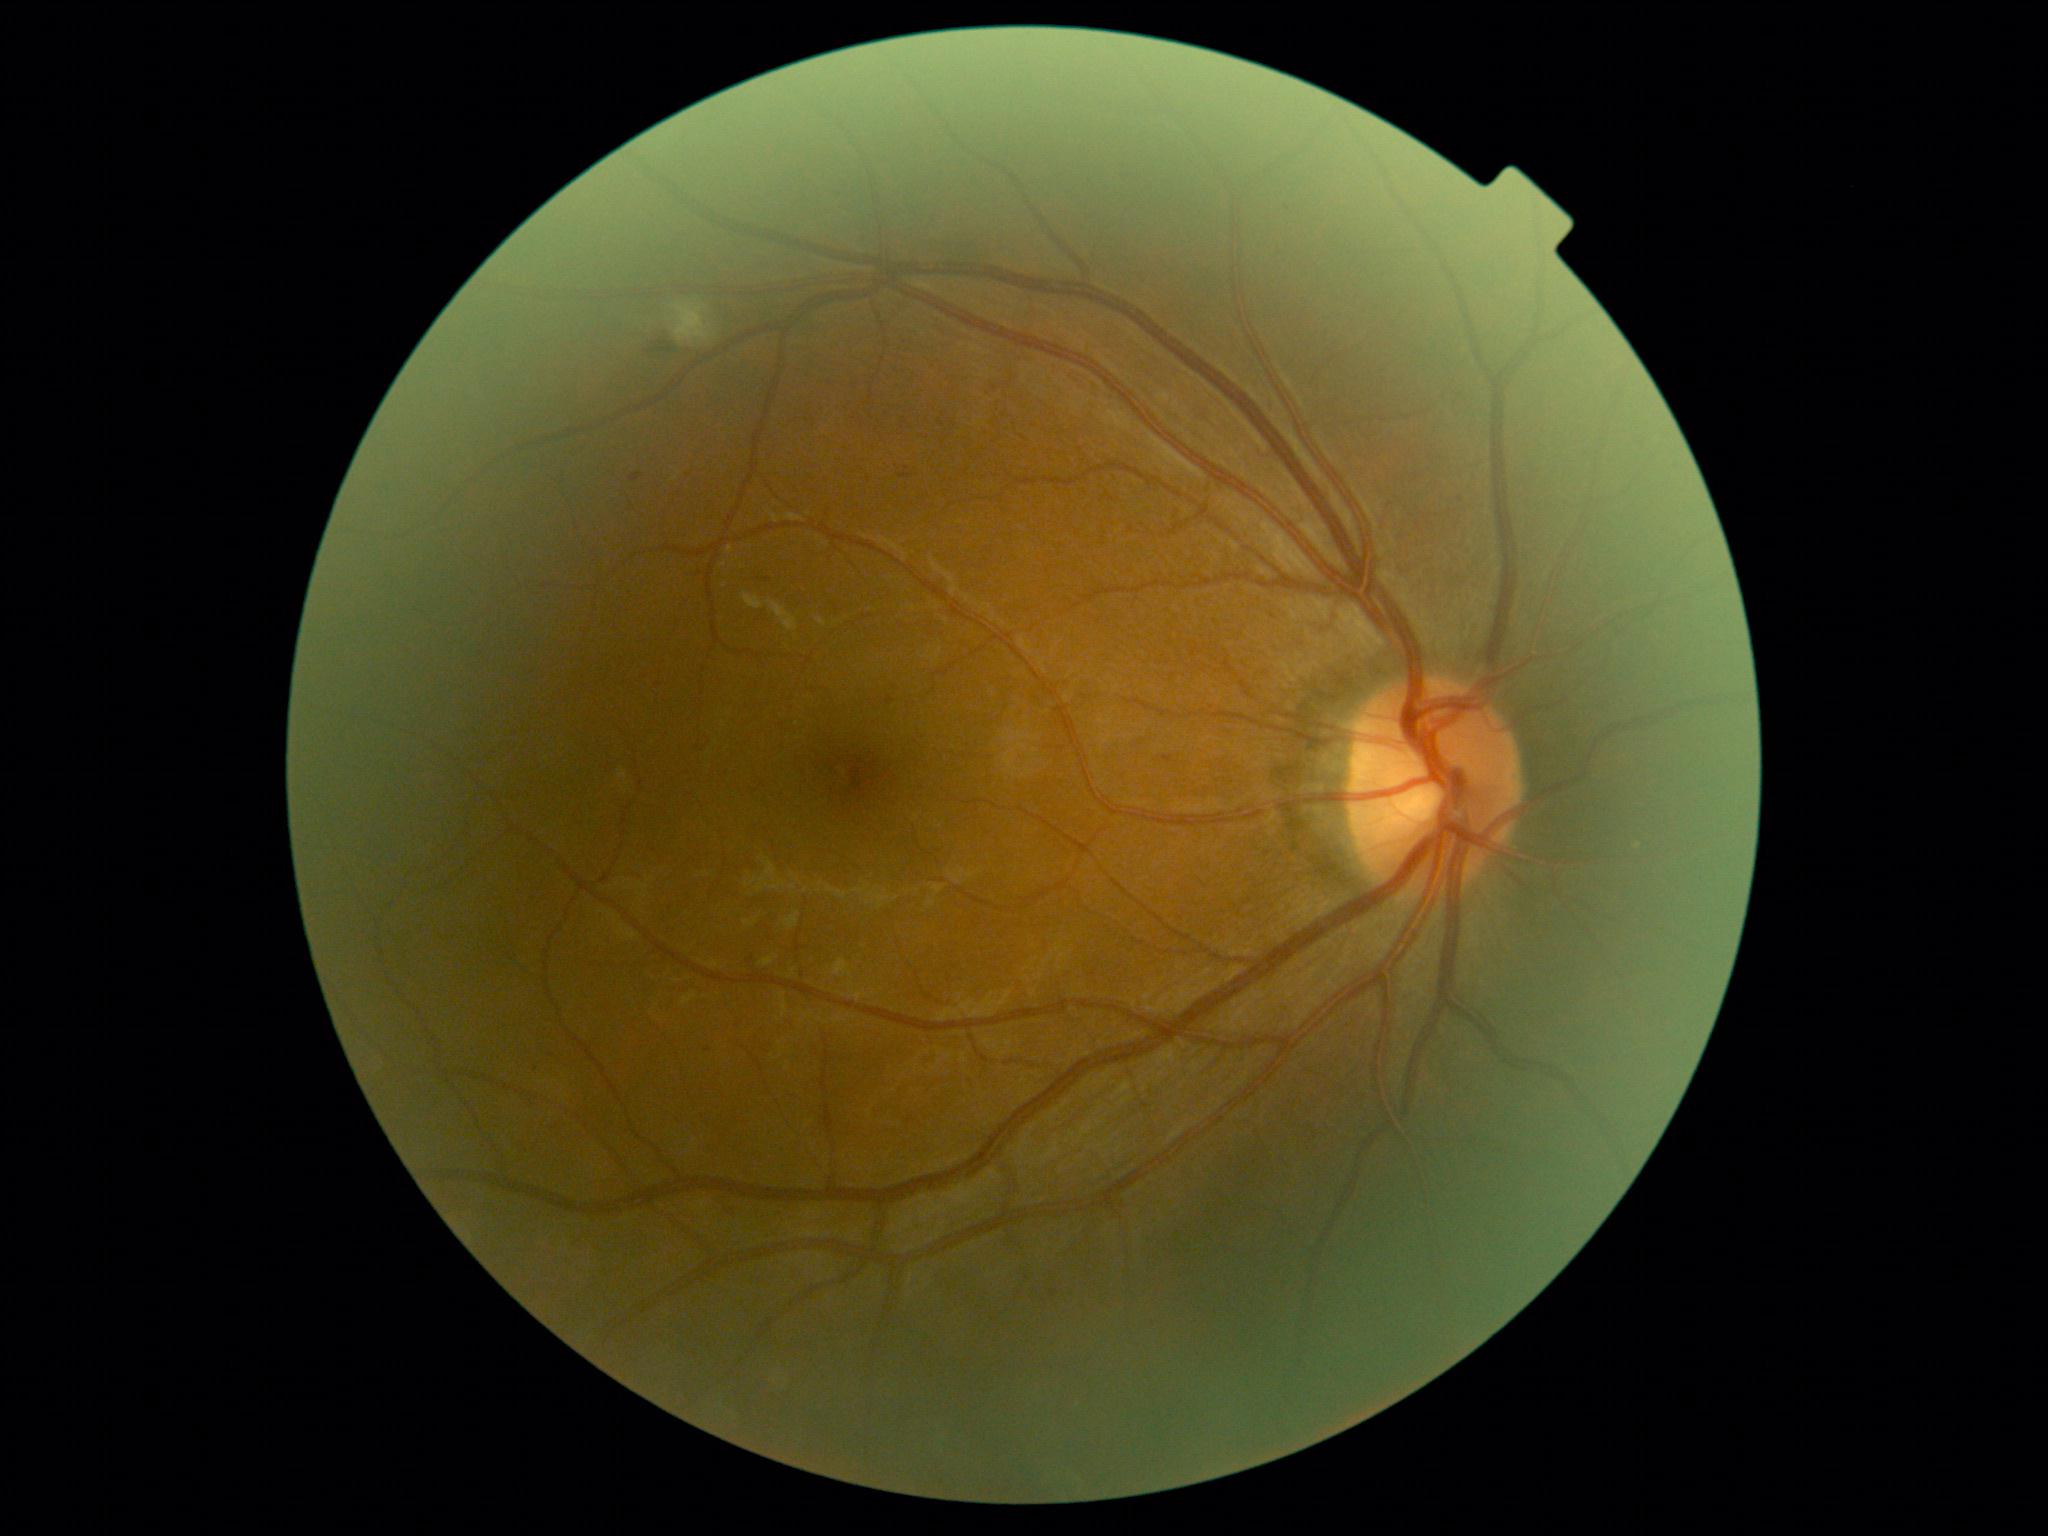

DR stage is 2.